DR severity per modified Davis staging: 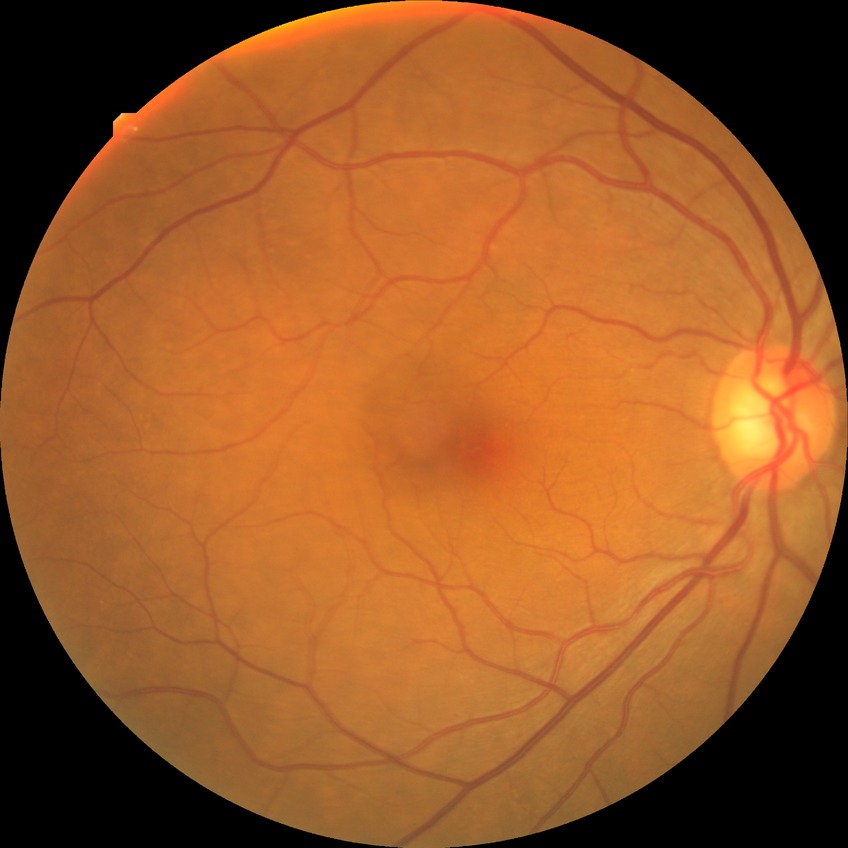 Diabetic retinopathy (DR) is no diabetic retinopathy (NDR).